Fundus photo; FOV: 45 degrees; 2048 x 1536 pixels: 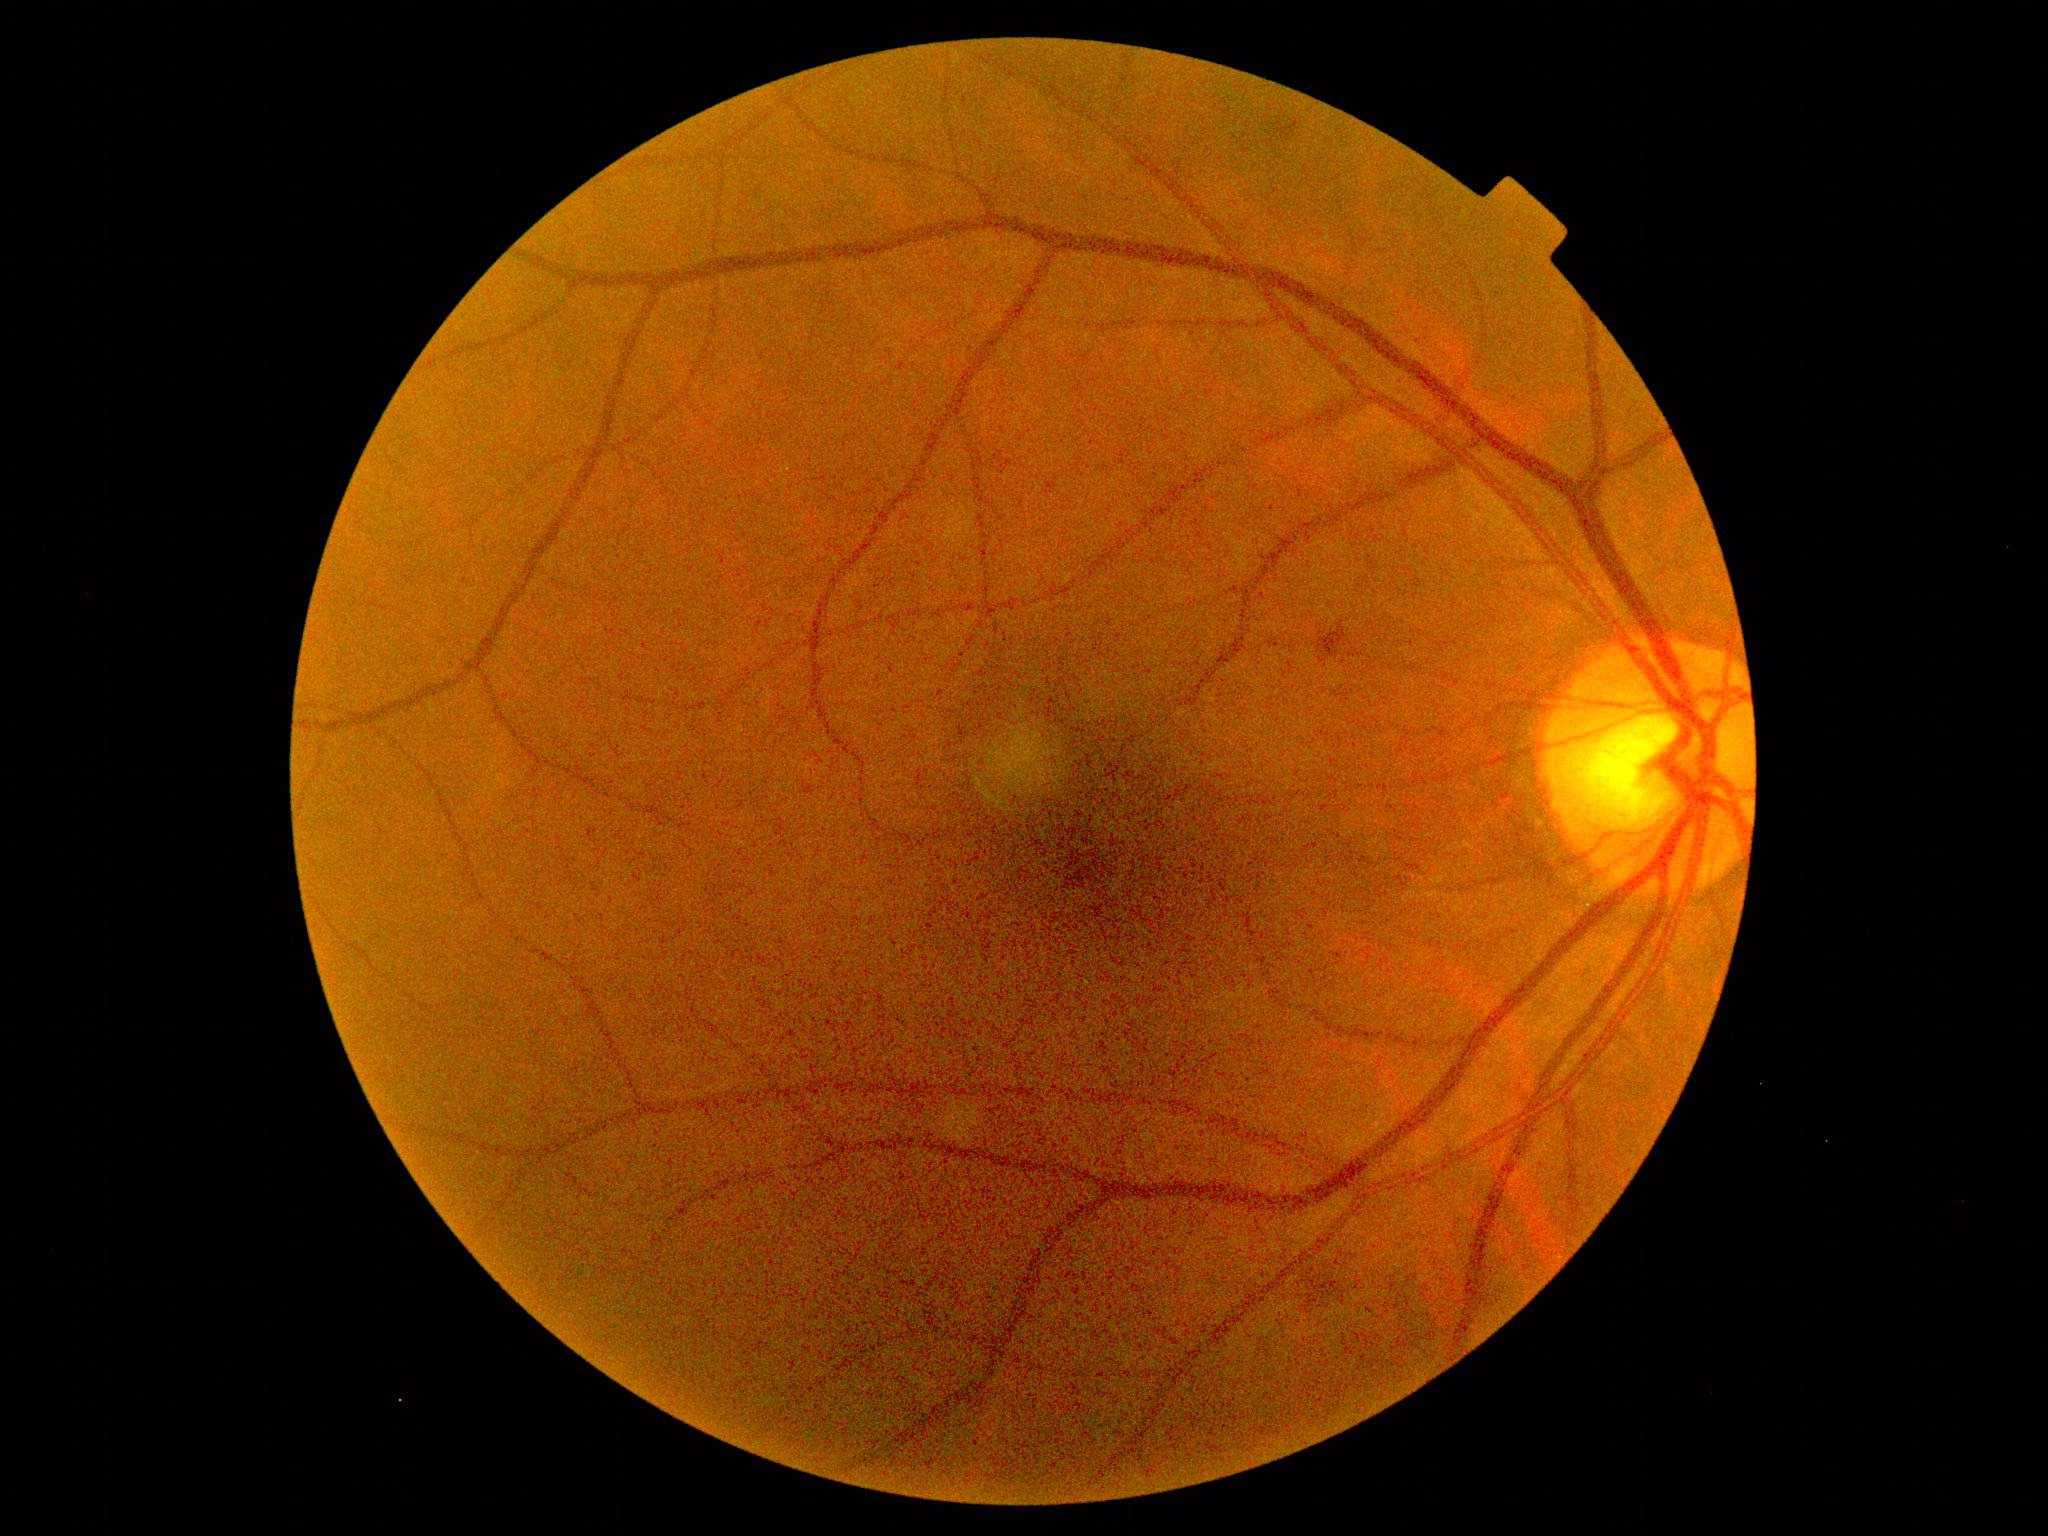 DR class: non-proliferative diabetic retinopathy | DR grade: moderate NPDR (2).